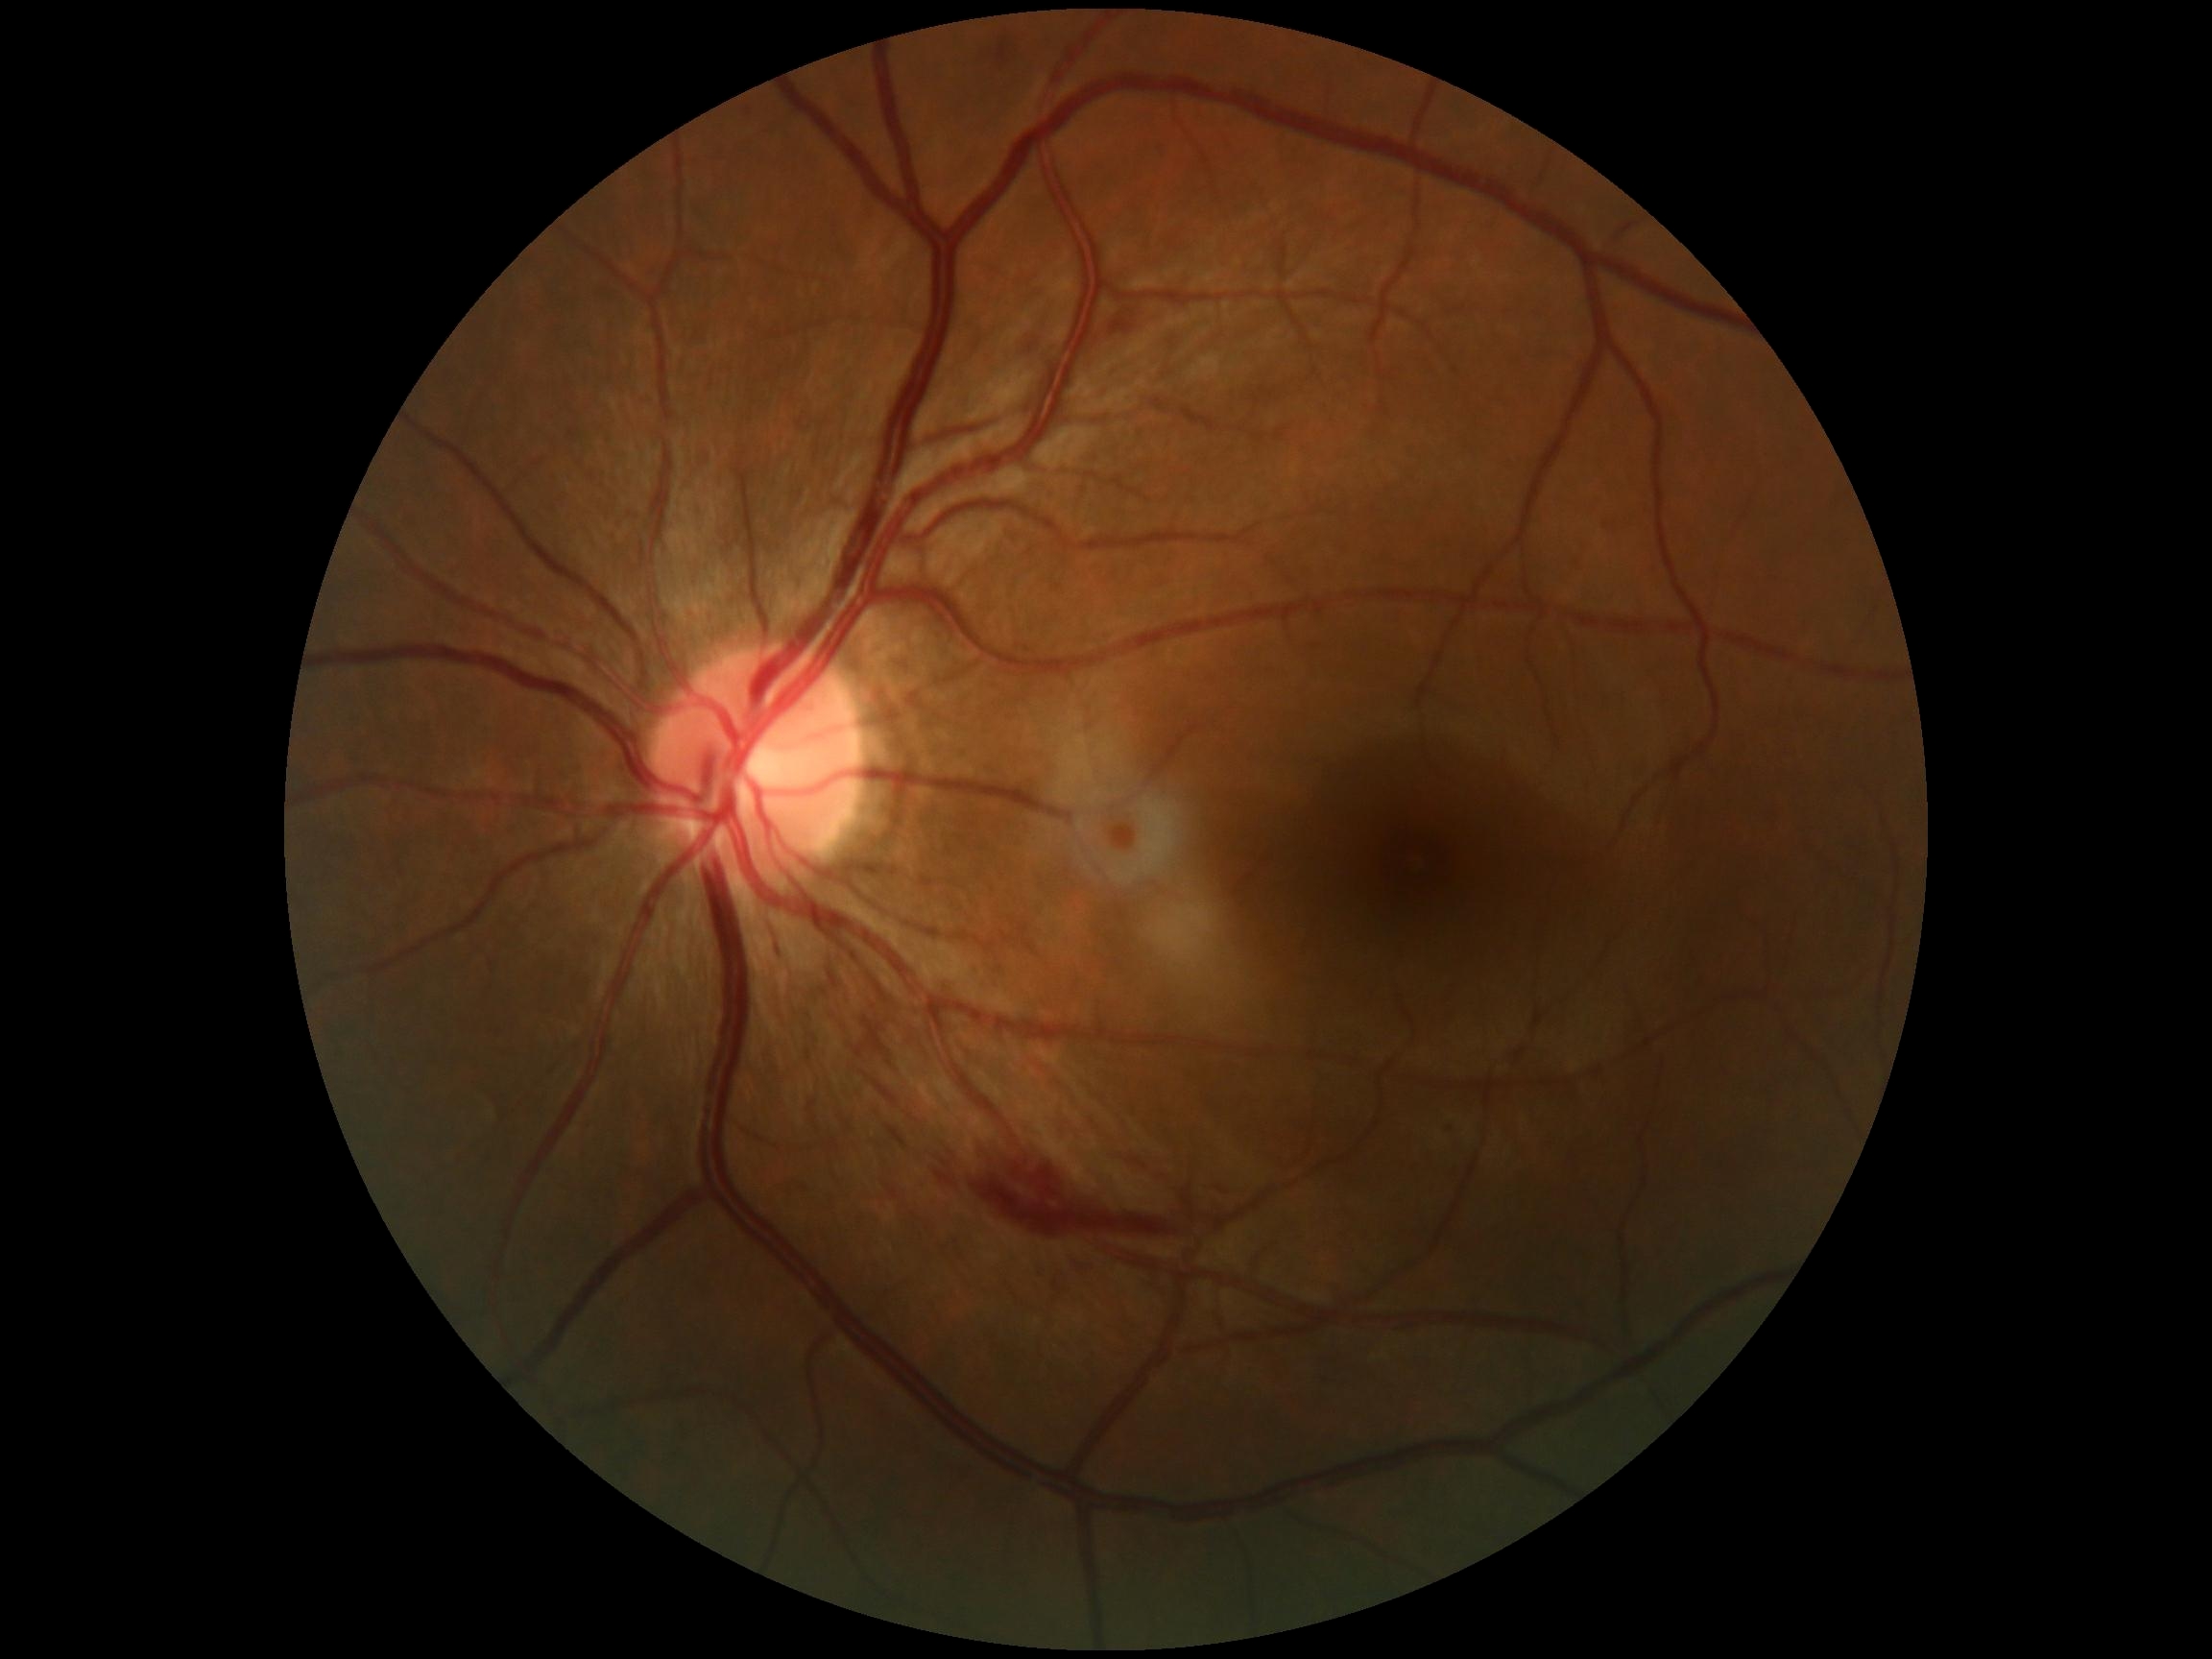

Diabetic retinopathy grade: 2.